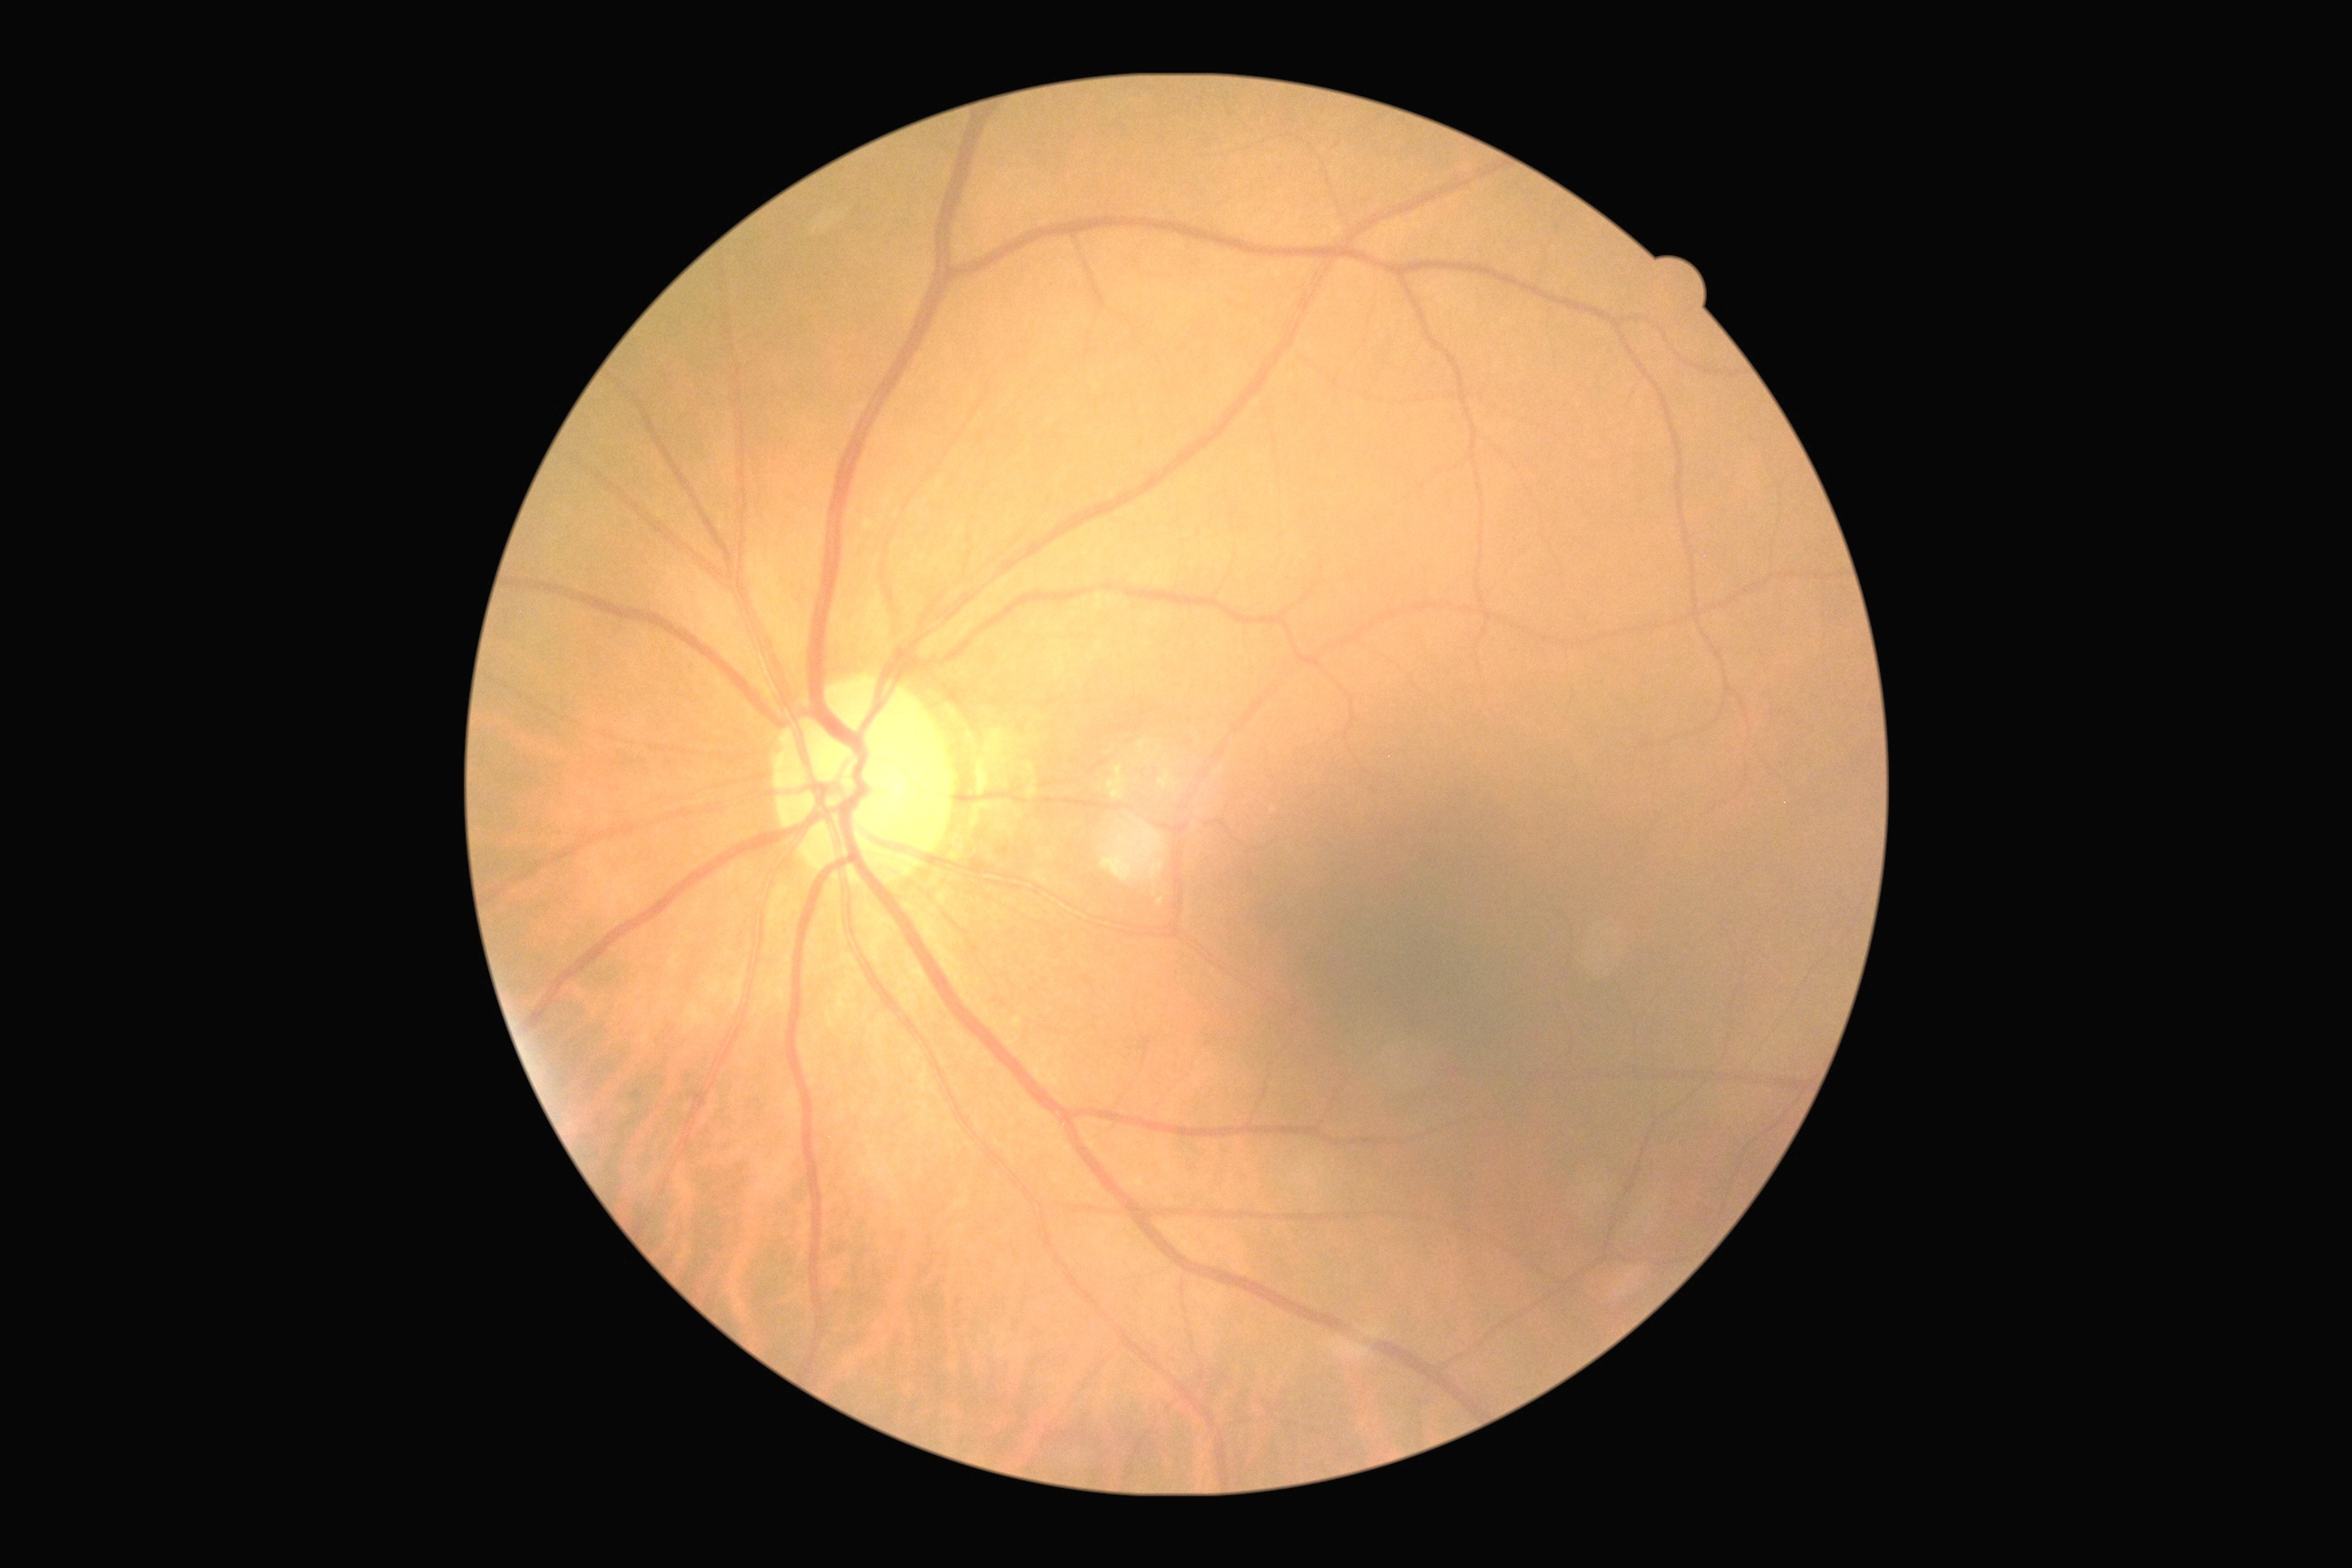

DR severity: 0/4 — no visible signs of diabetic retinopathy.
No signs of diabetic retinopathy.